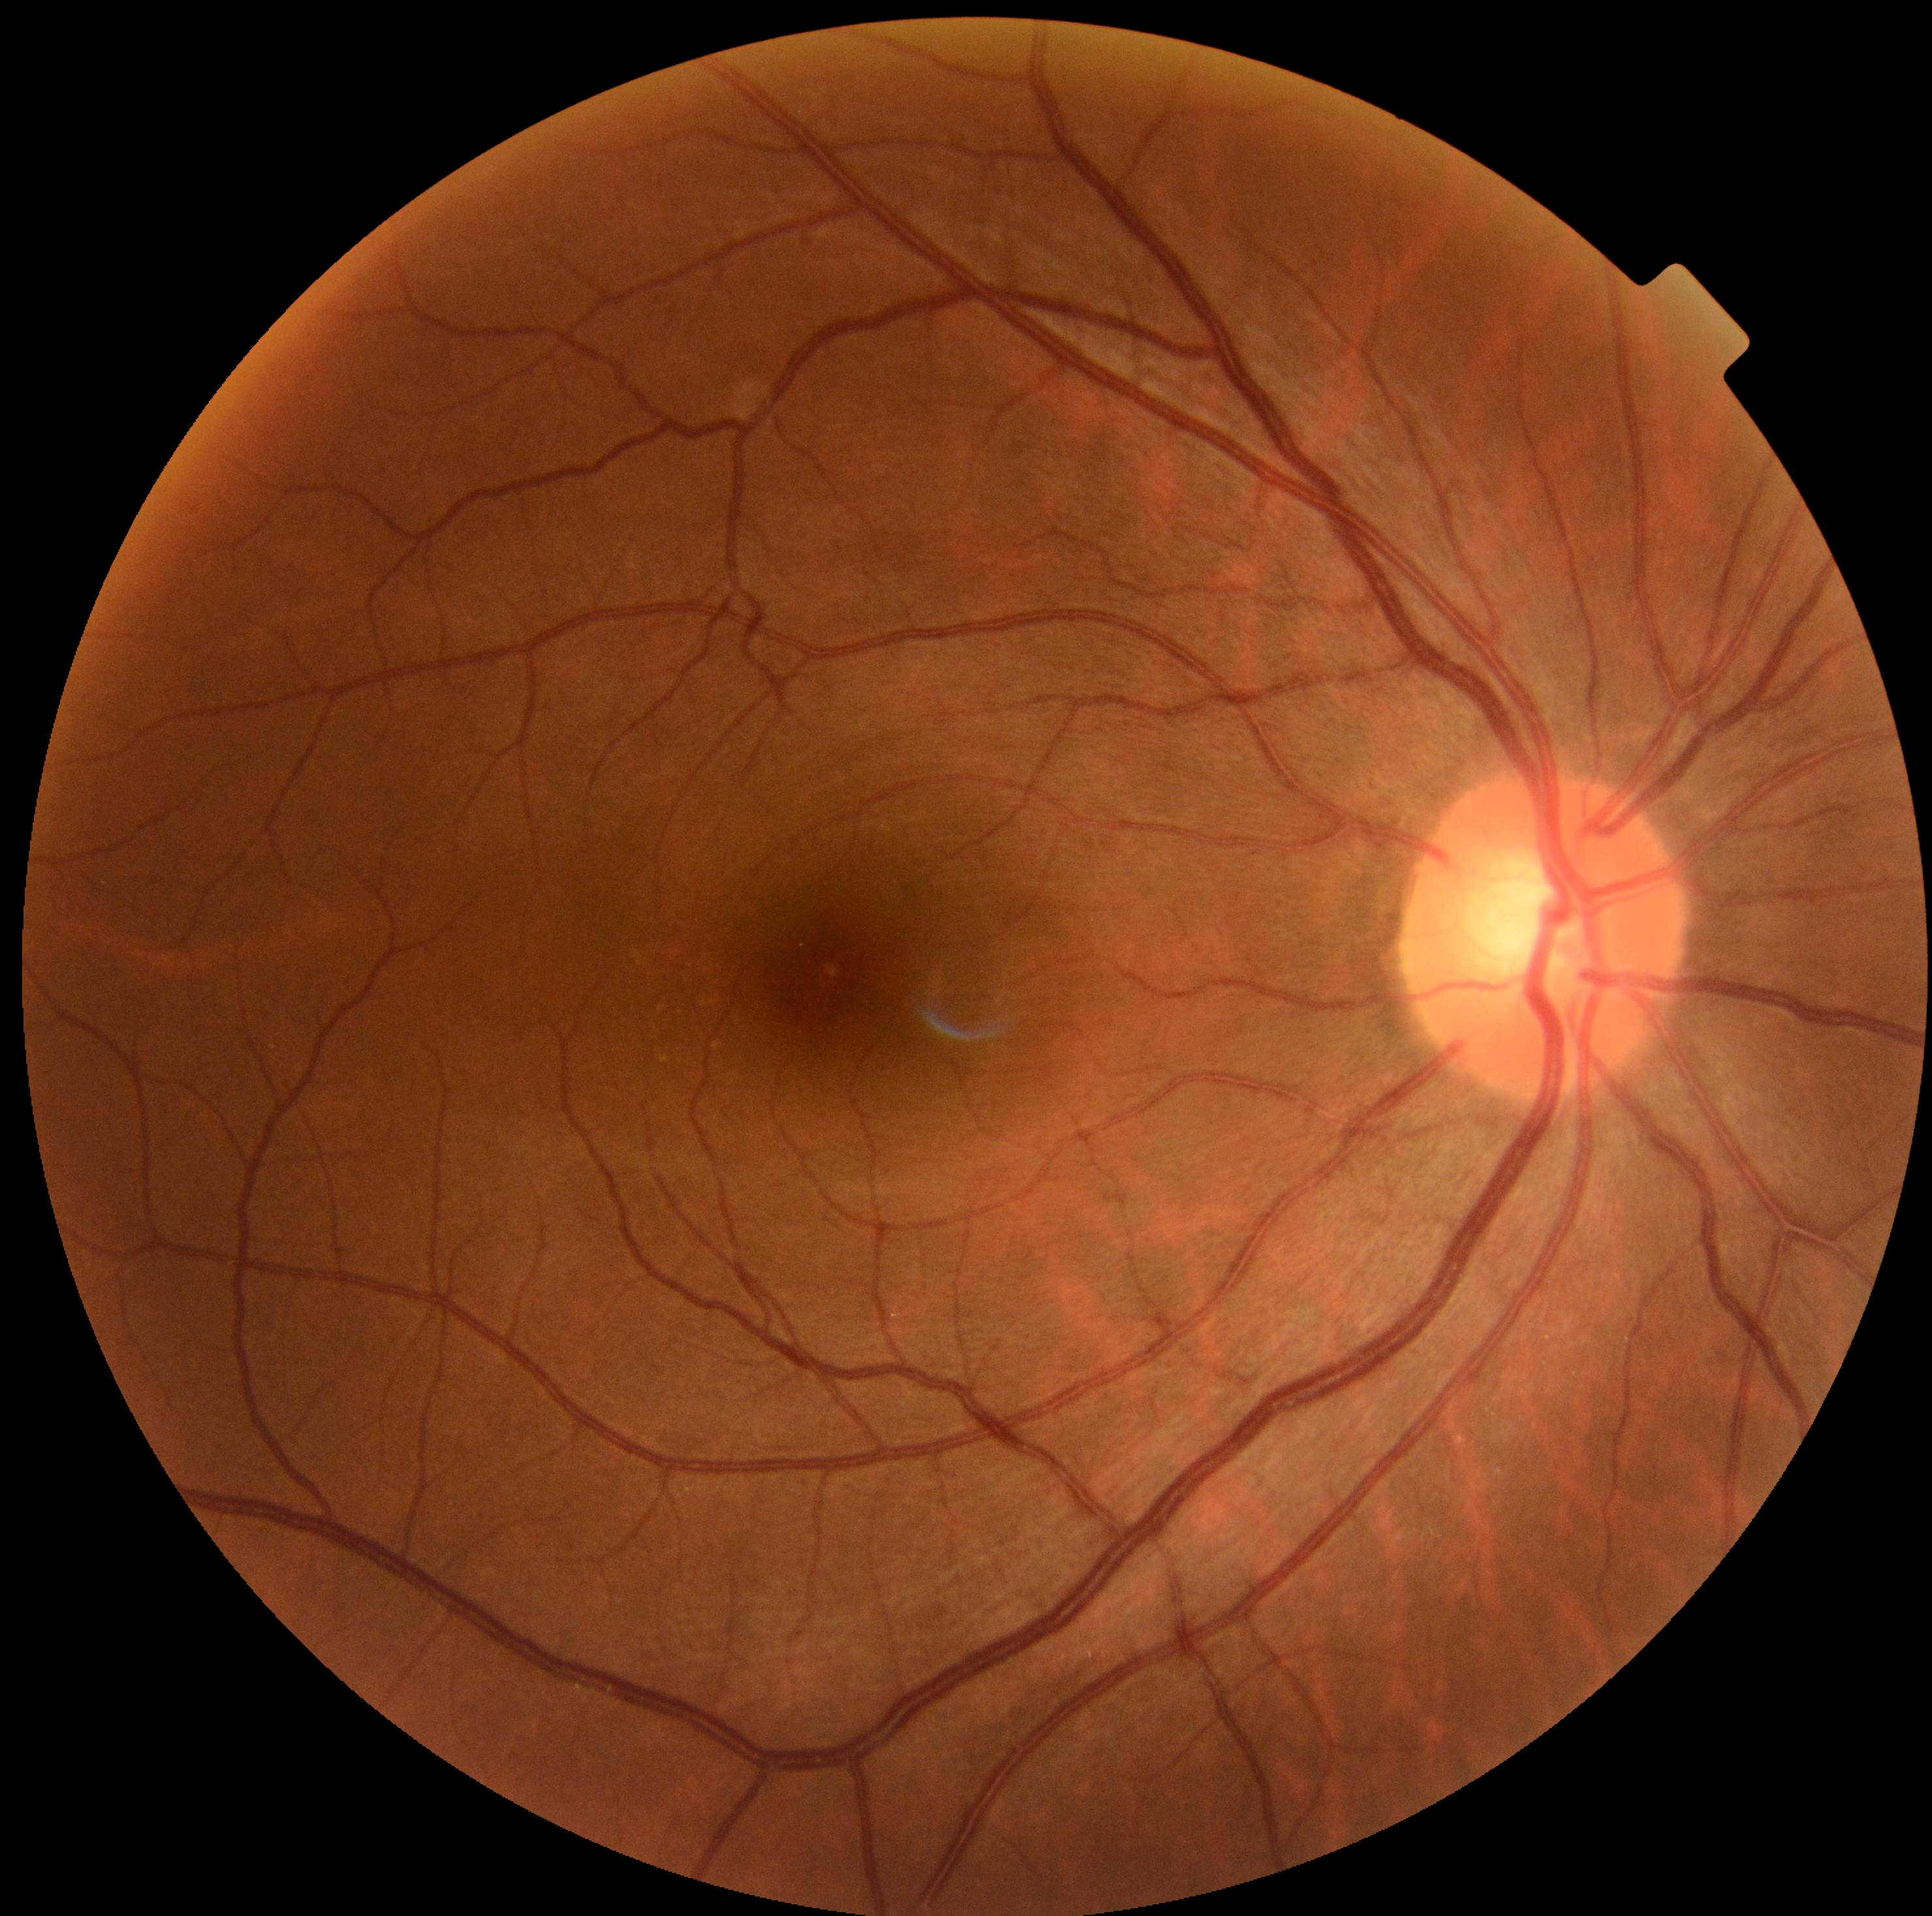
No signs of diabetic retinopathy. DR grade is no apparent retinopathy (0) — no visible signs of diabetic retinopathy.